Modified Davis classification, 848x848
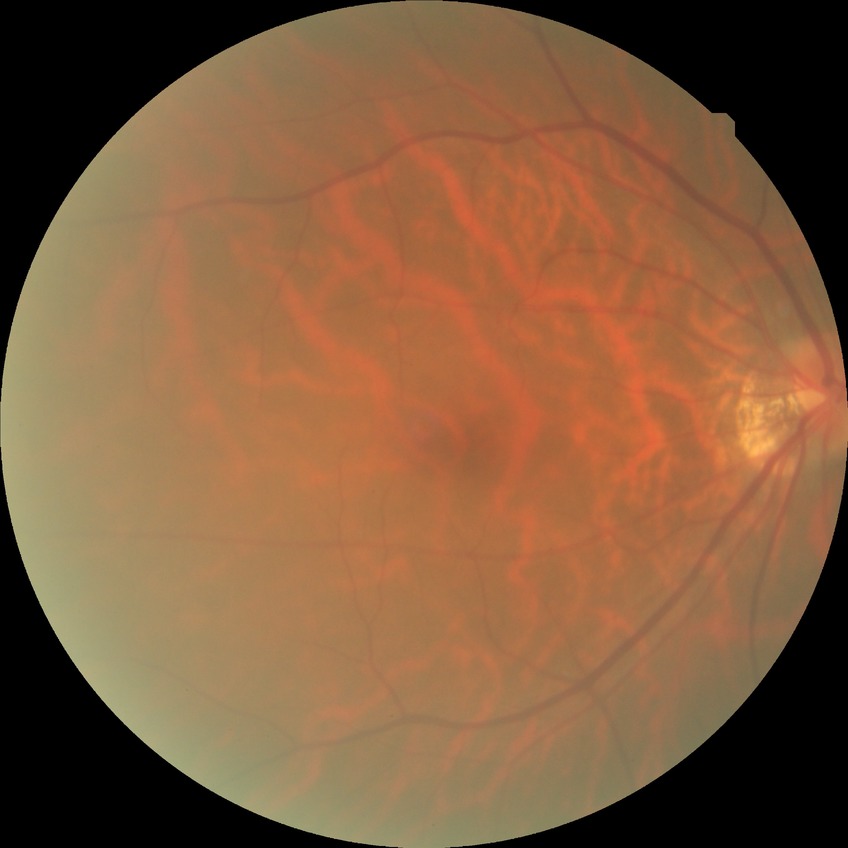

diabetic retinopathy (DR) = NDR (no diabetic retinopathy).